1240x1240. Pediatric retinal photograph (wide-field): 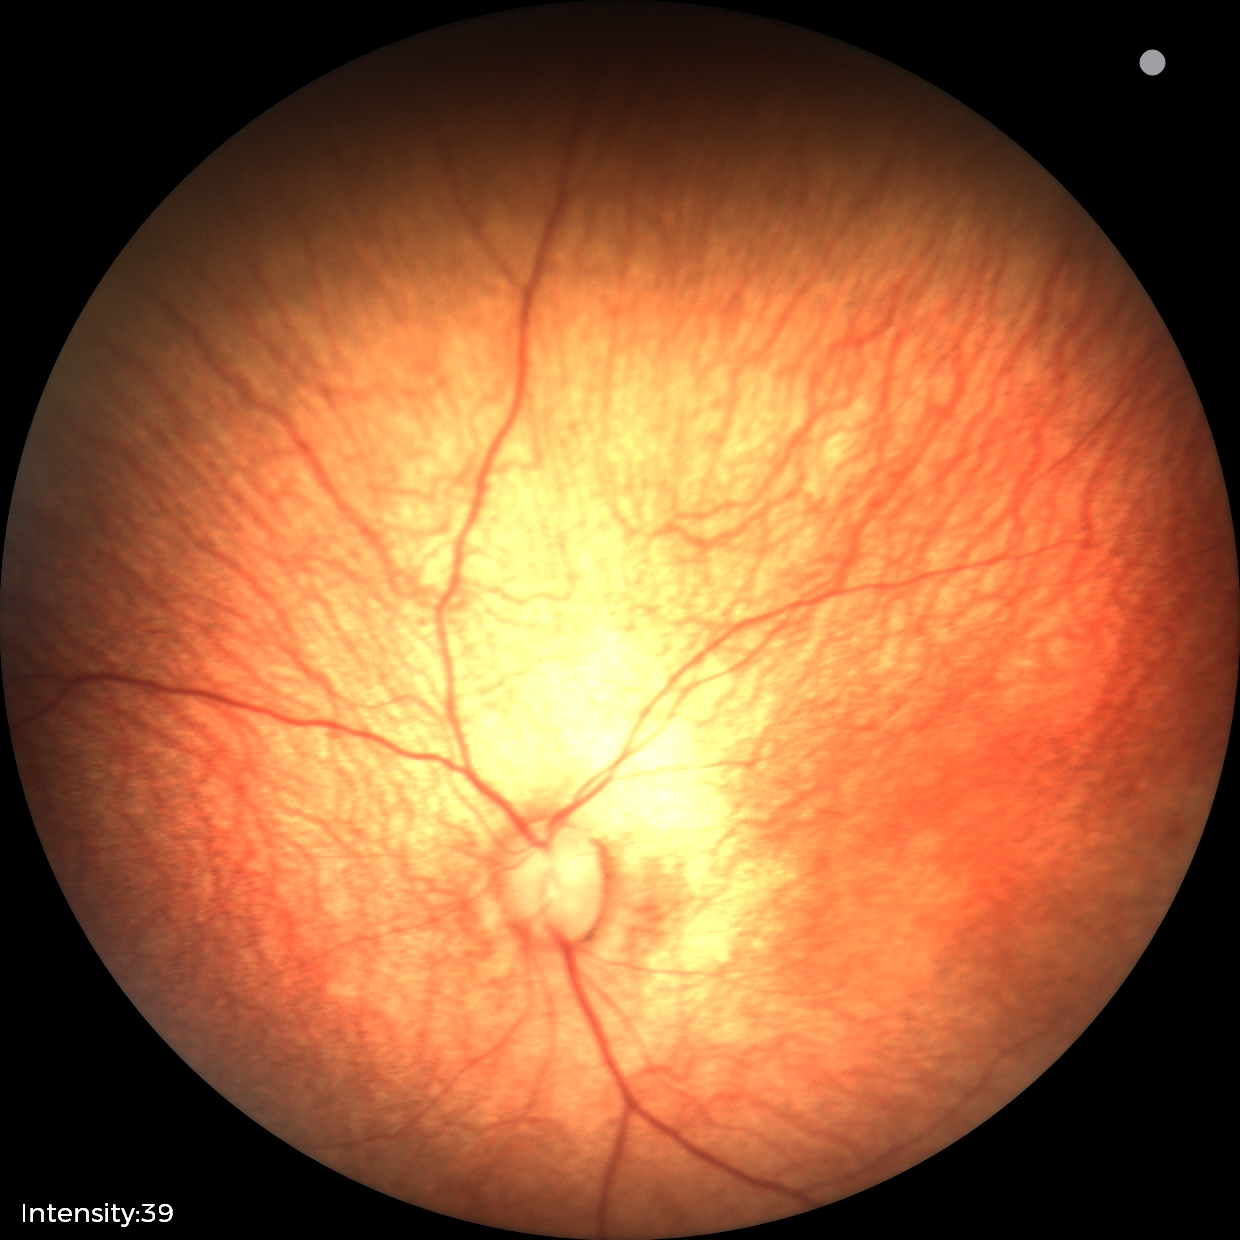
Normal screening examination.